Wide-field fundus photograph from neonatal ROP screening
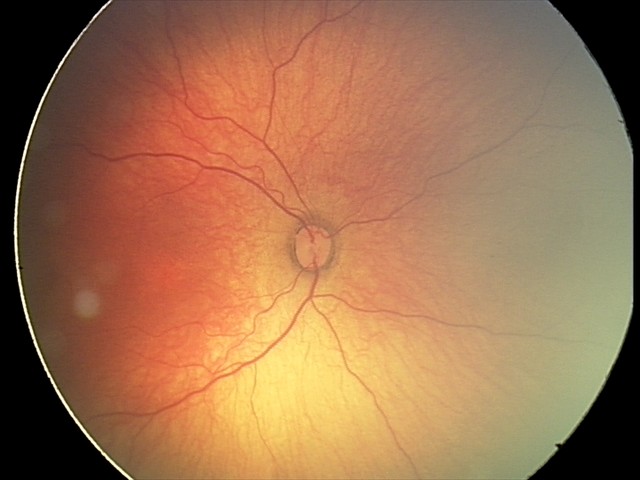

Plus form: absent; diagnosis: status post ROP.